2352 by 1568 pixels; CFP:
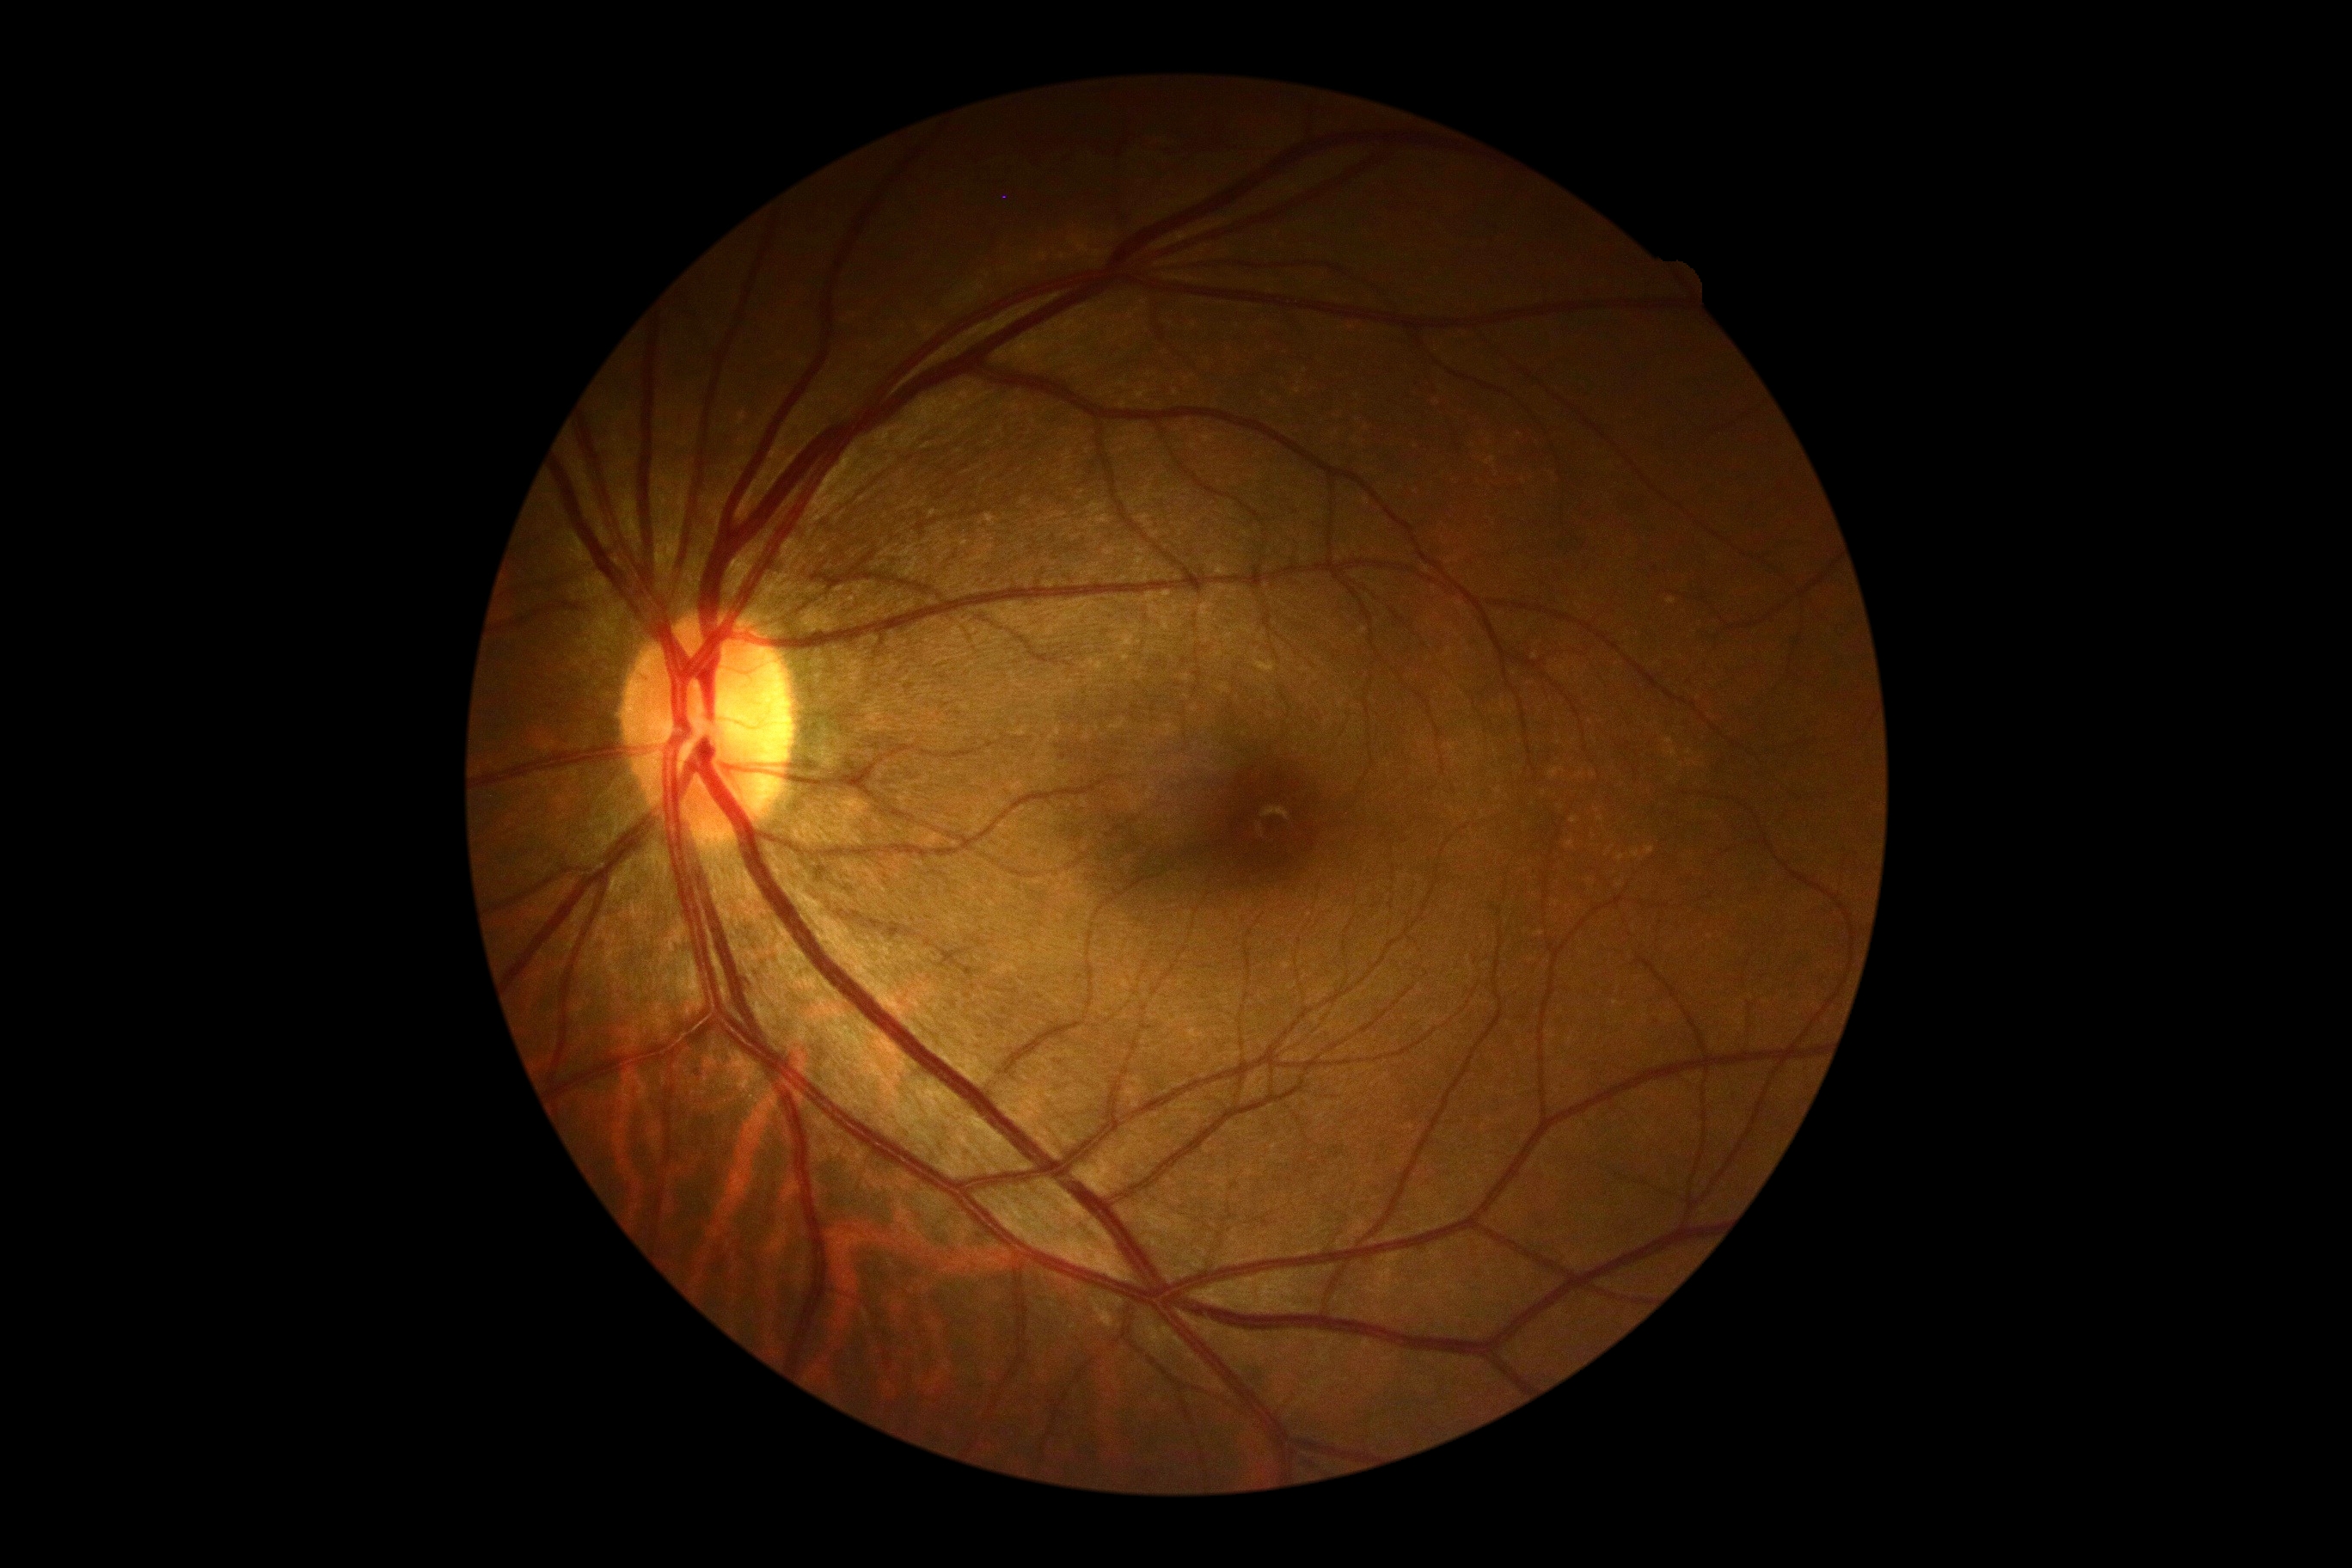

Retinopathy is grade 0.